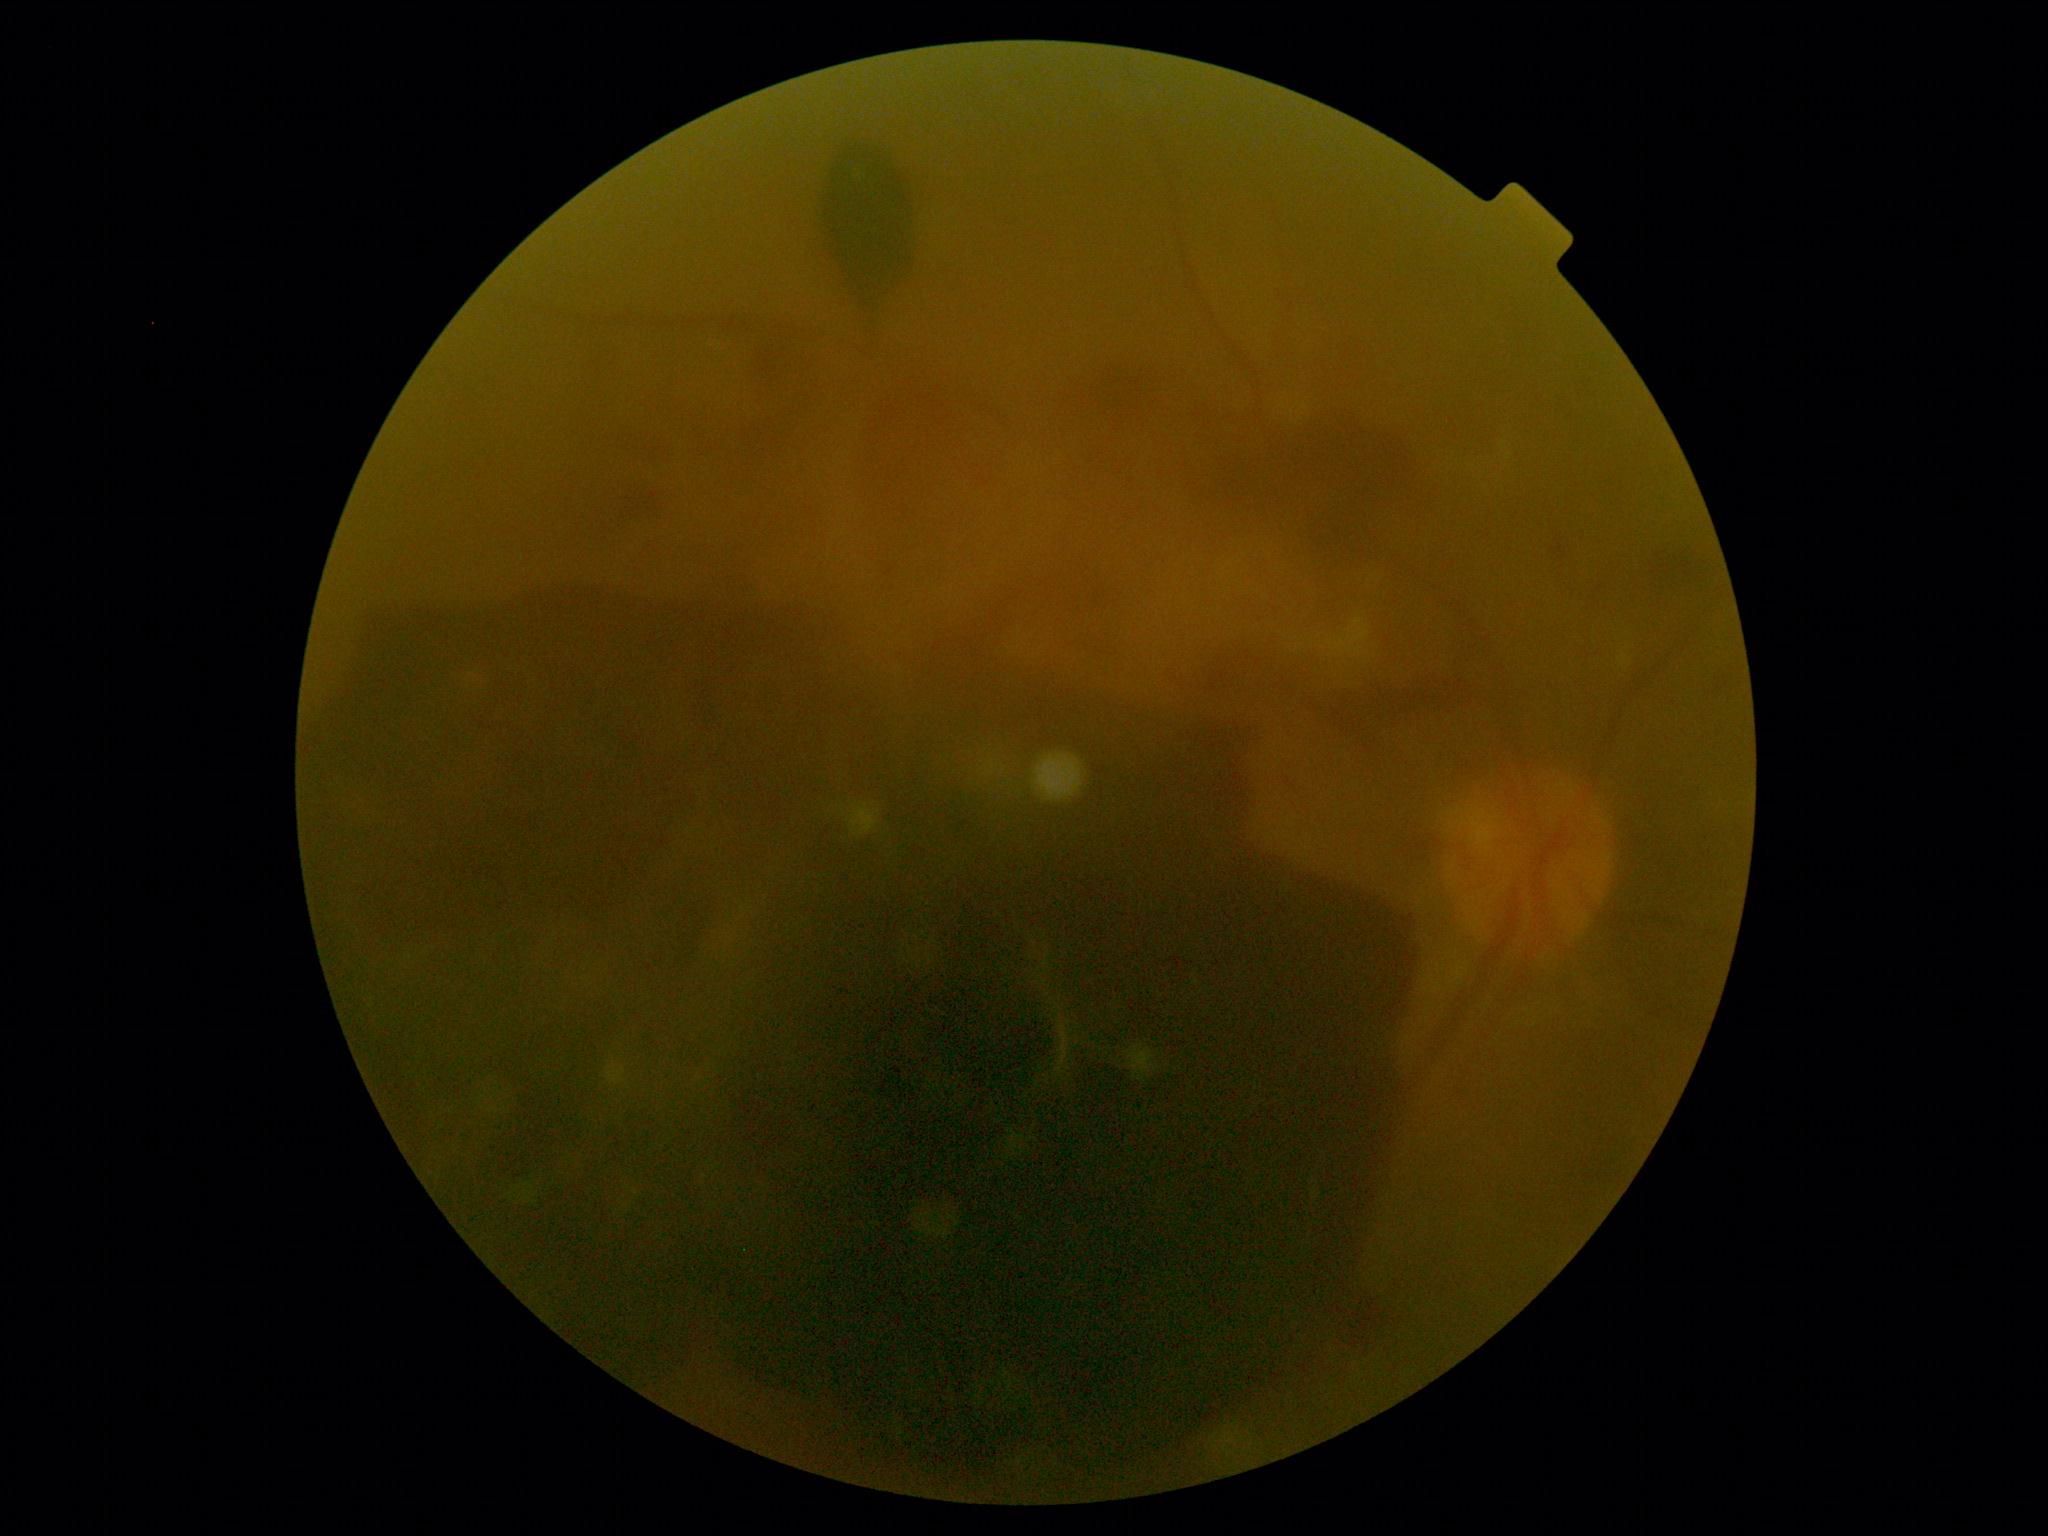

Retinopathy grade is 4.